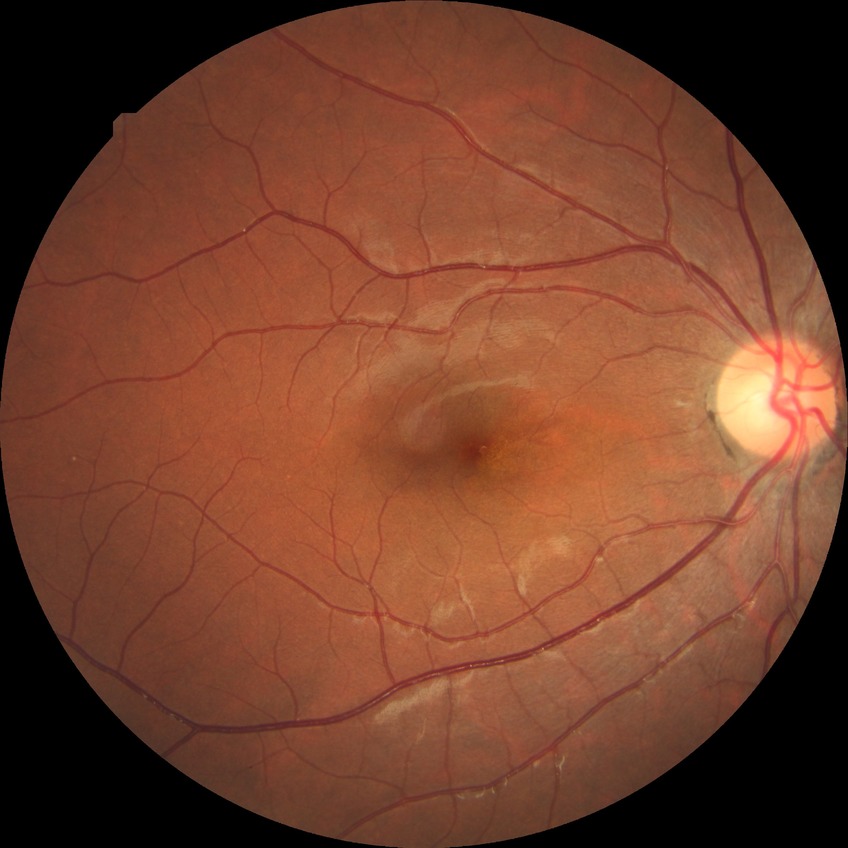 Modified Davis grade: NDR.
No diabetic retinal disease findings.